Image size 2212x1659
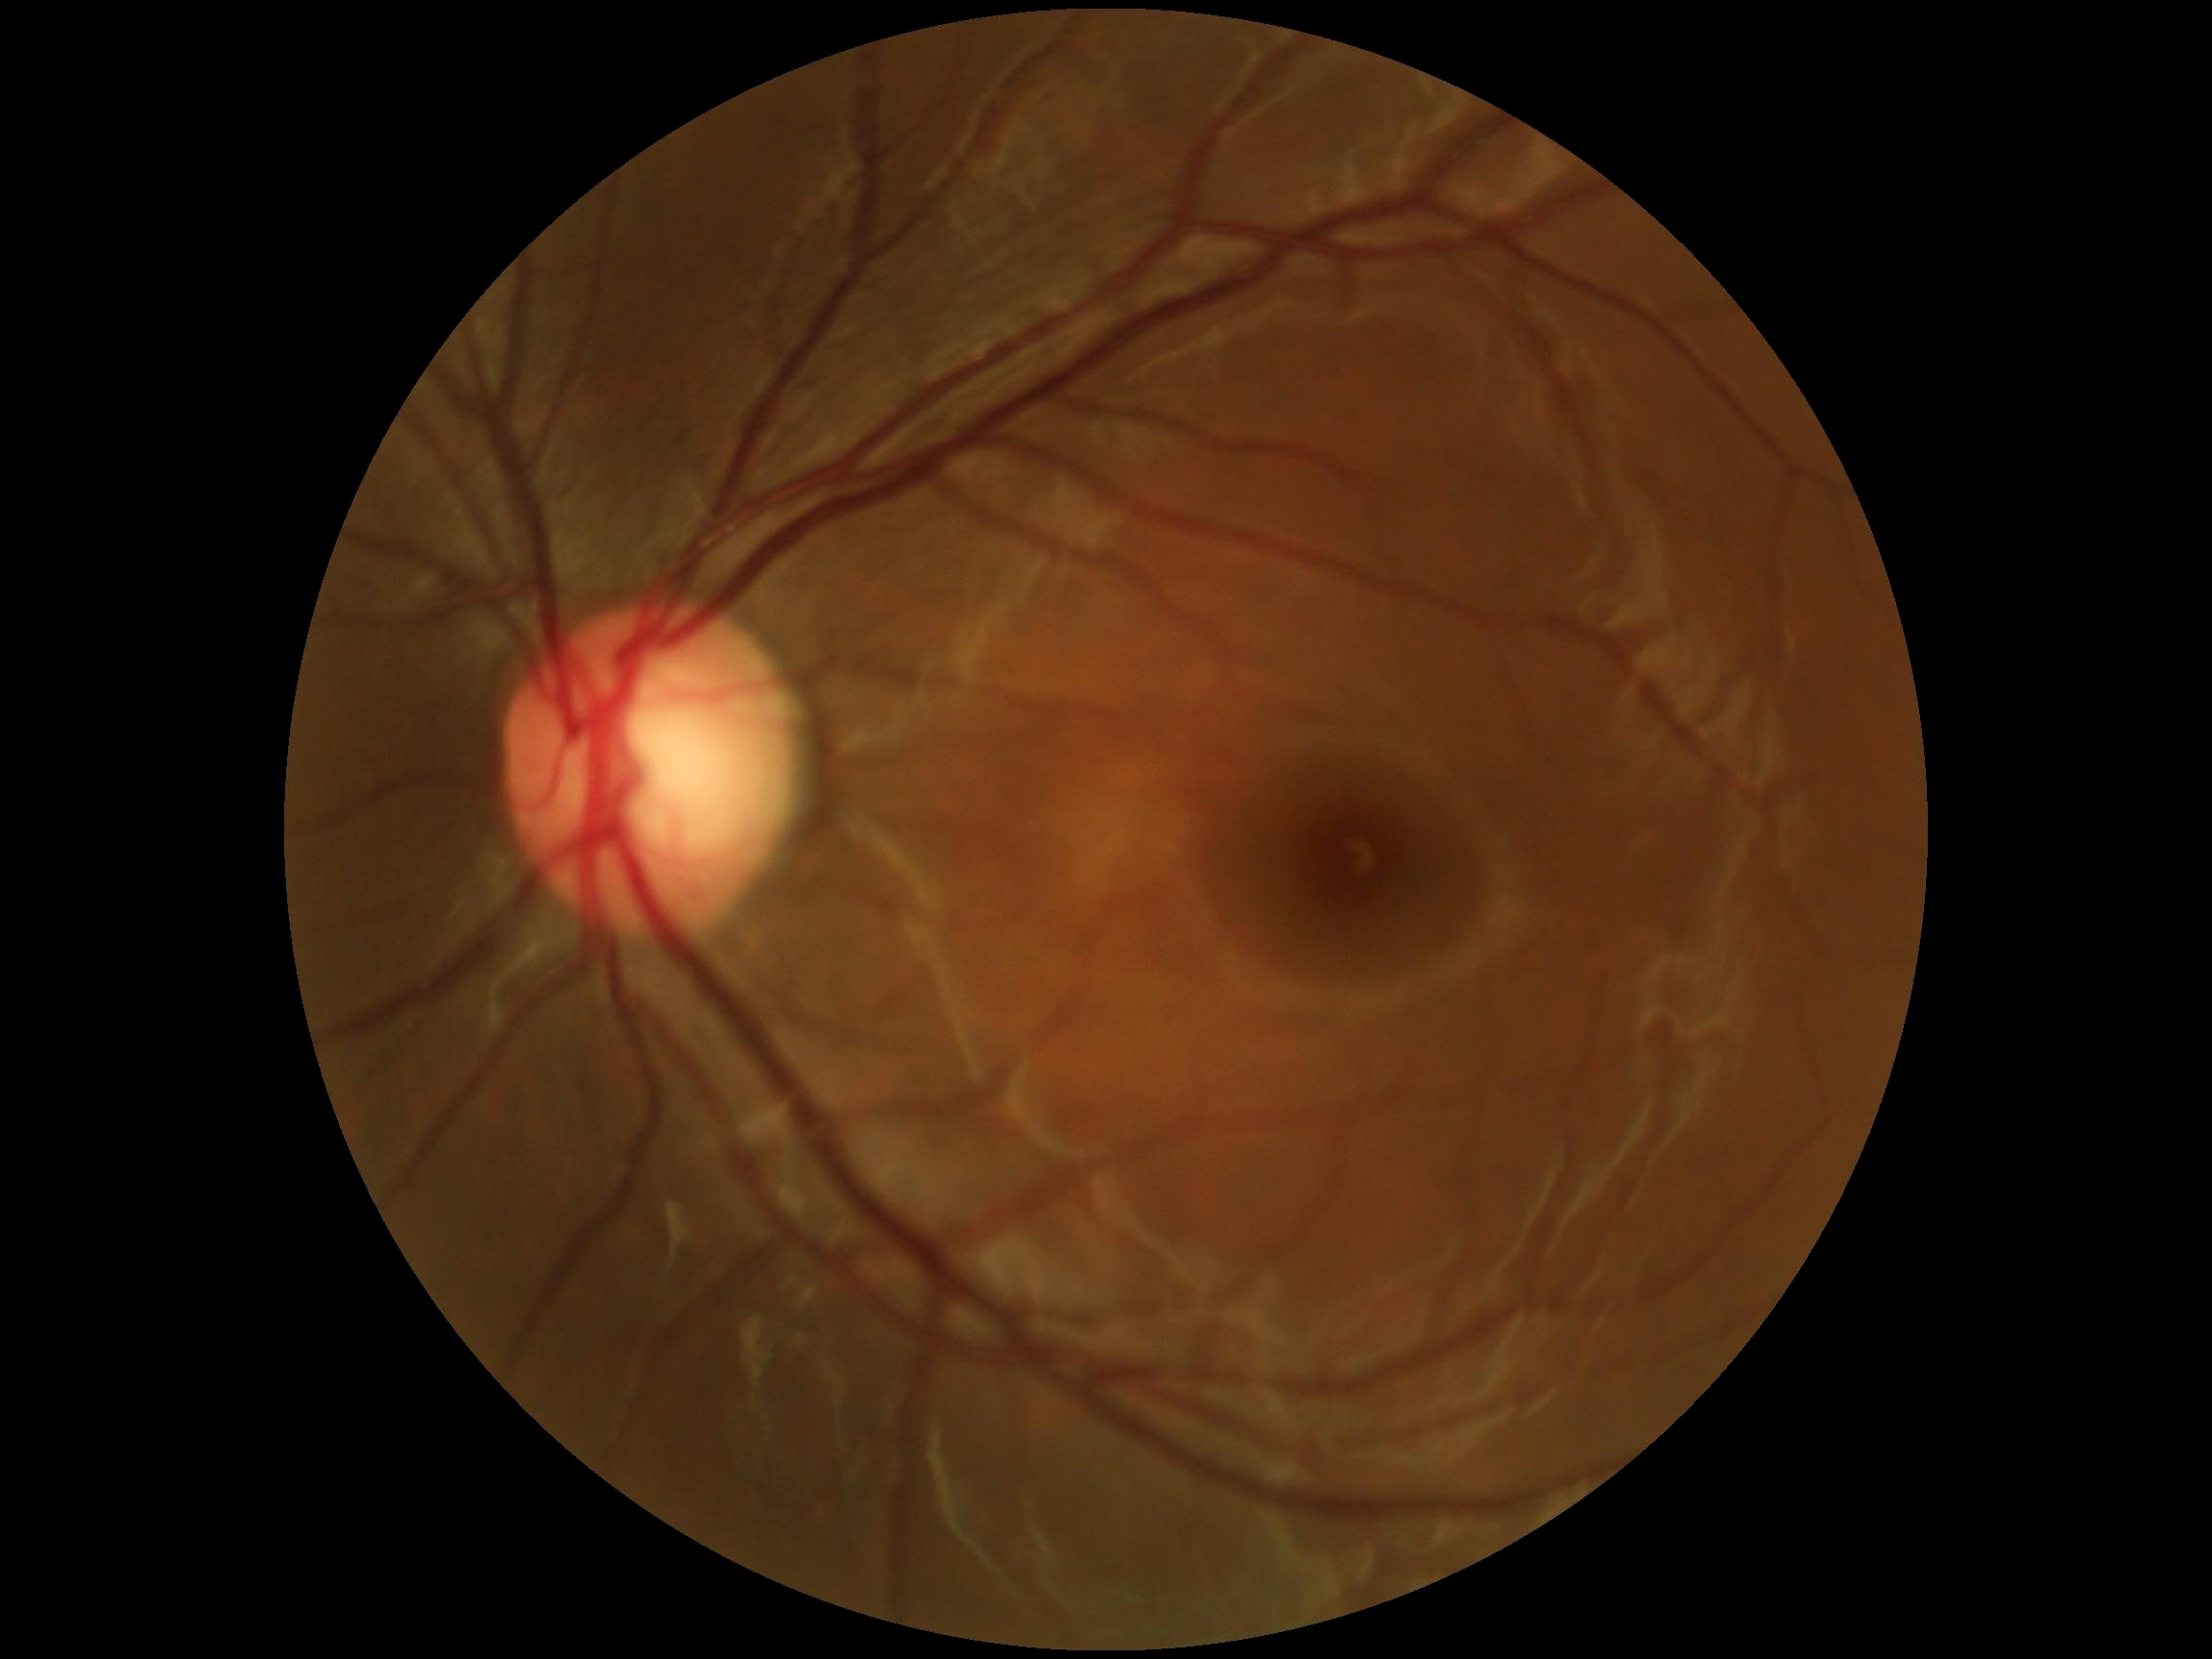 DR impression = negative for DR, retinopathy = grade 0 (no apparent retinopathy).